Retinal fundus photograph
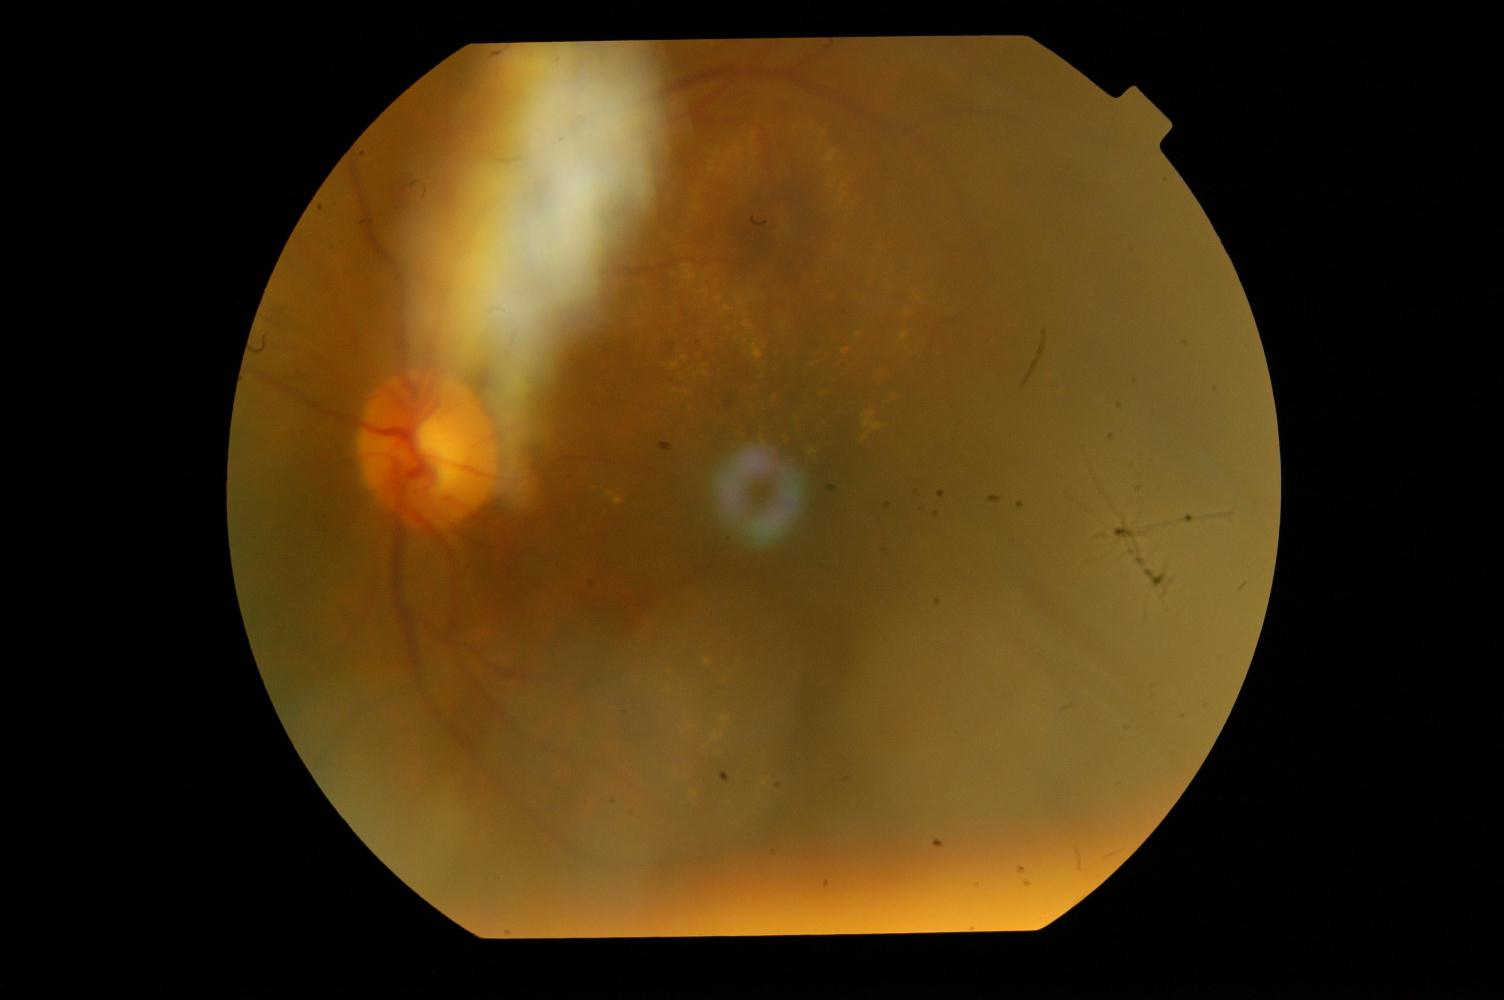

Demonstrates diabetic retinopathy.